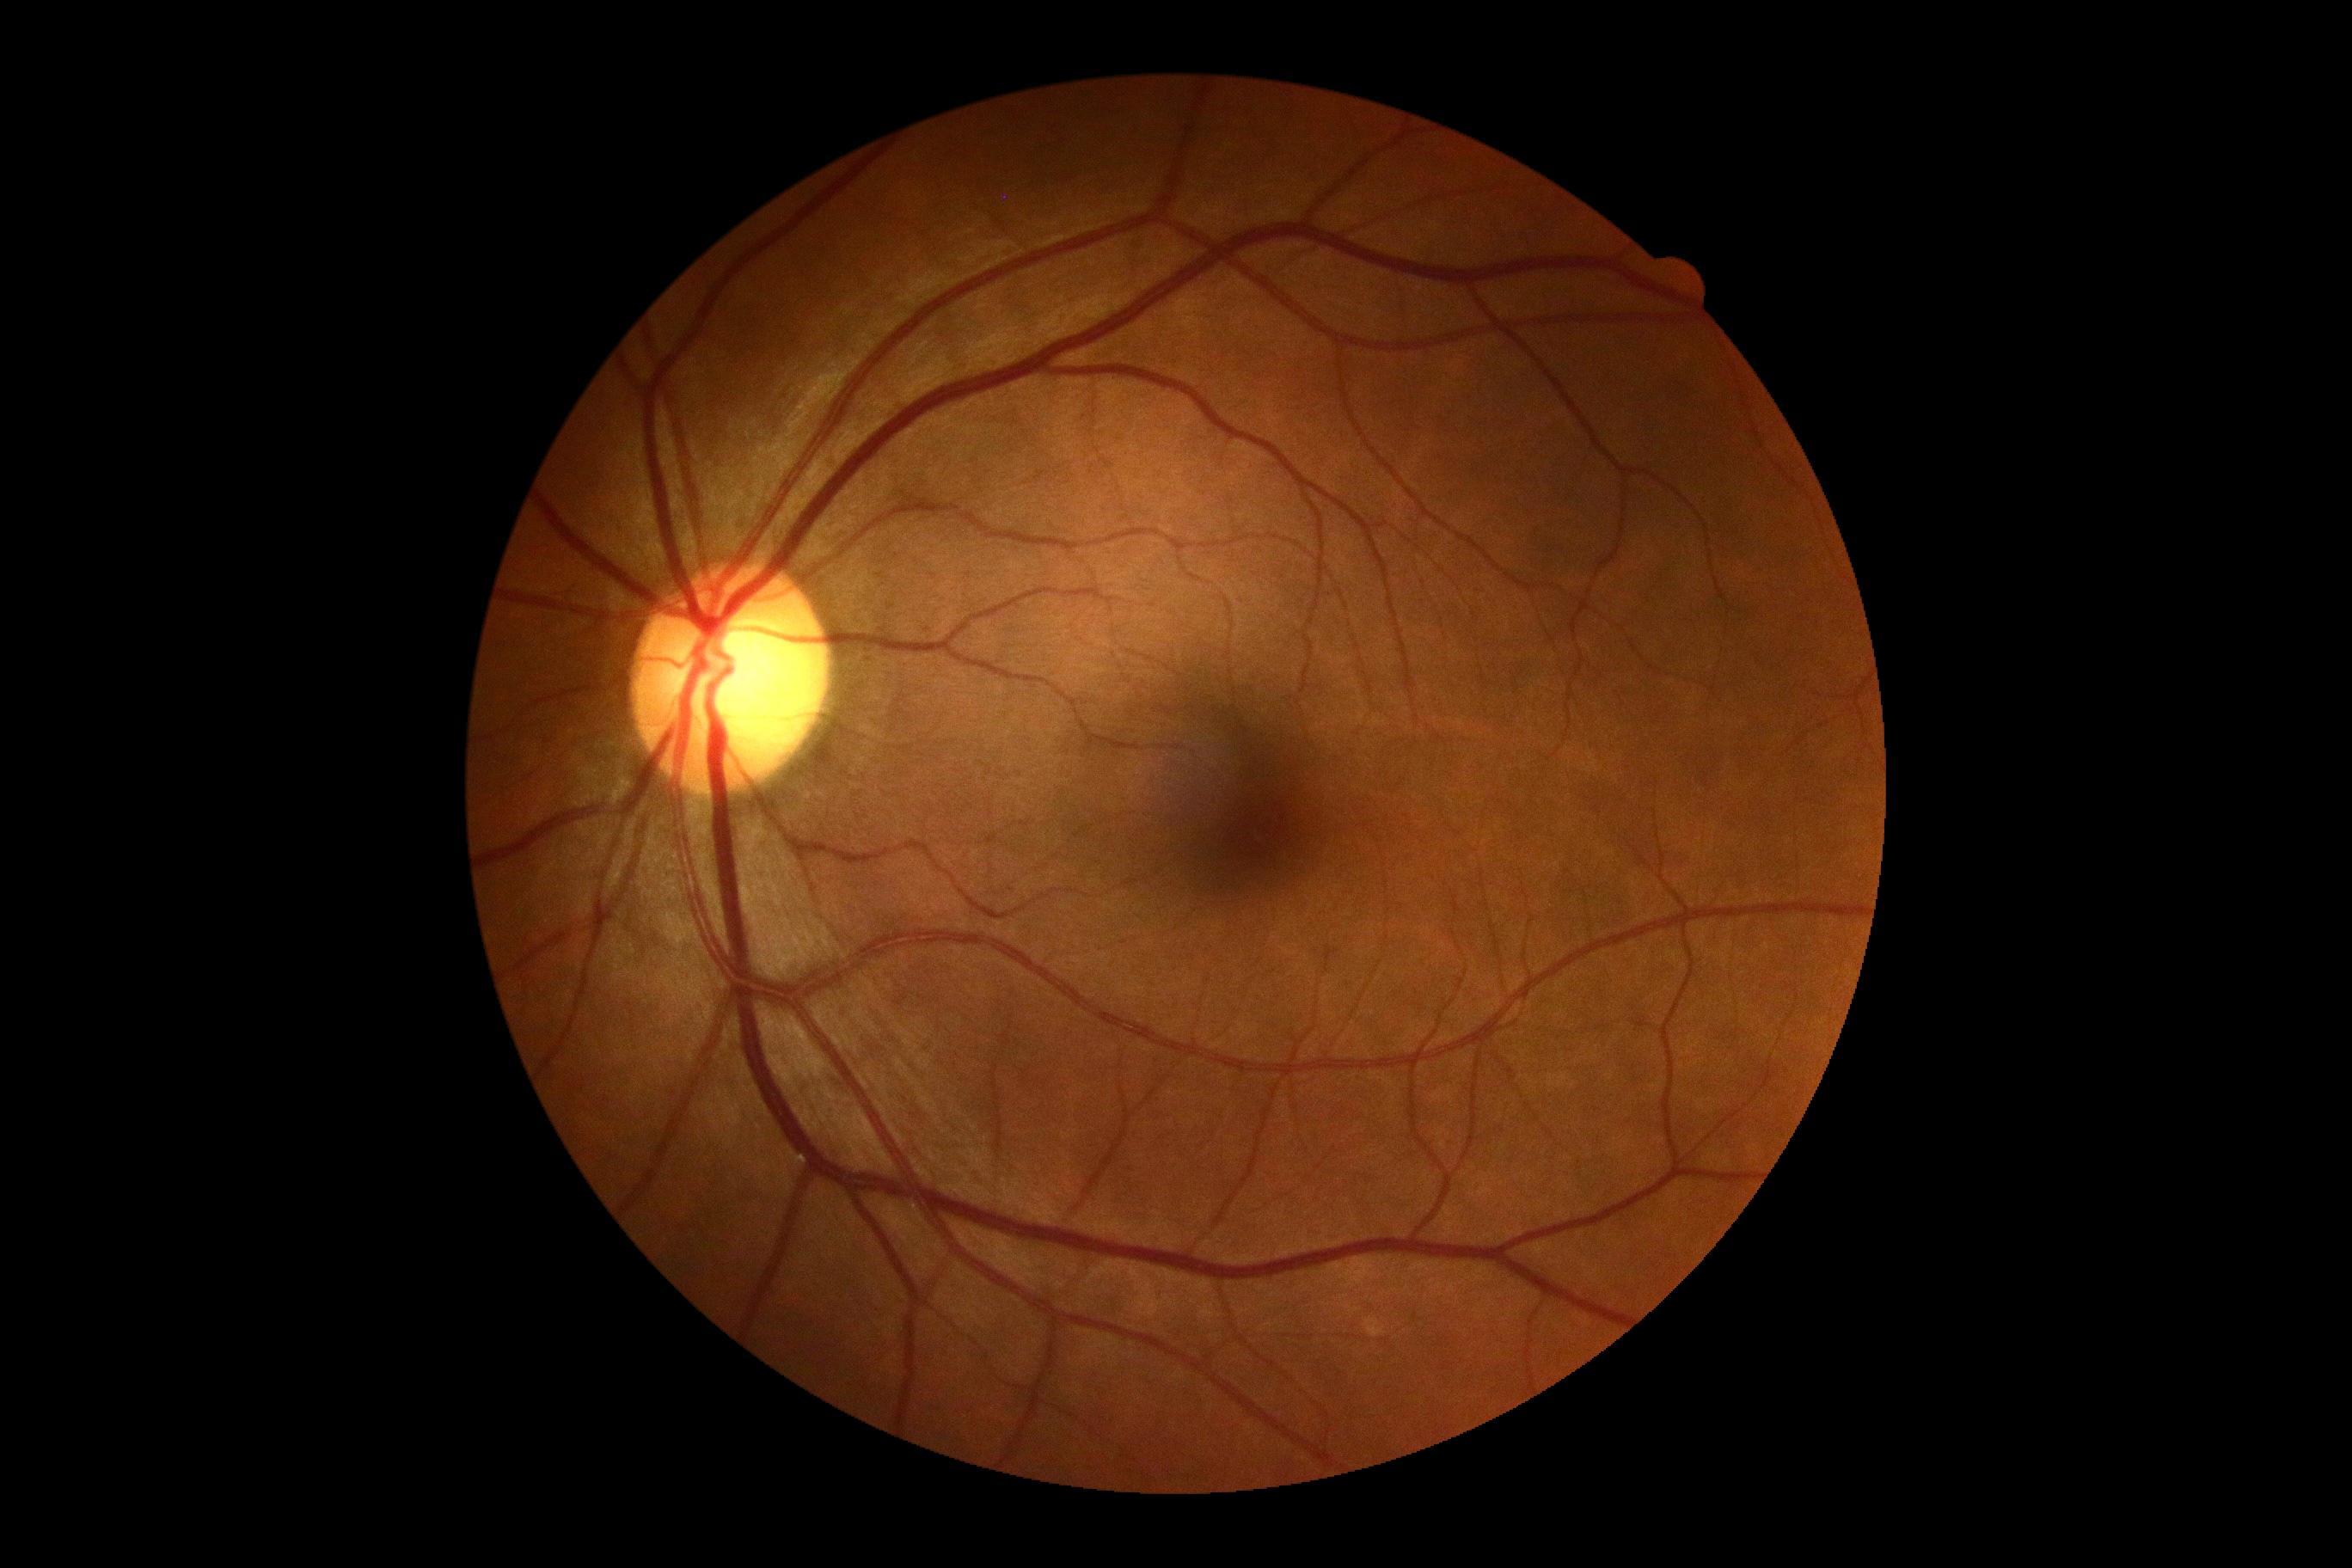

Diabetic retinopathy (DR): no apparent retinopathy (grade 0).